DR severity per modified Davis staging; camera: NIDEK AFC-230.
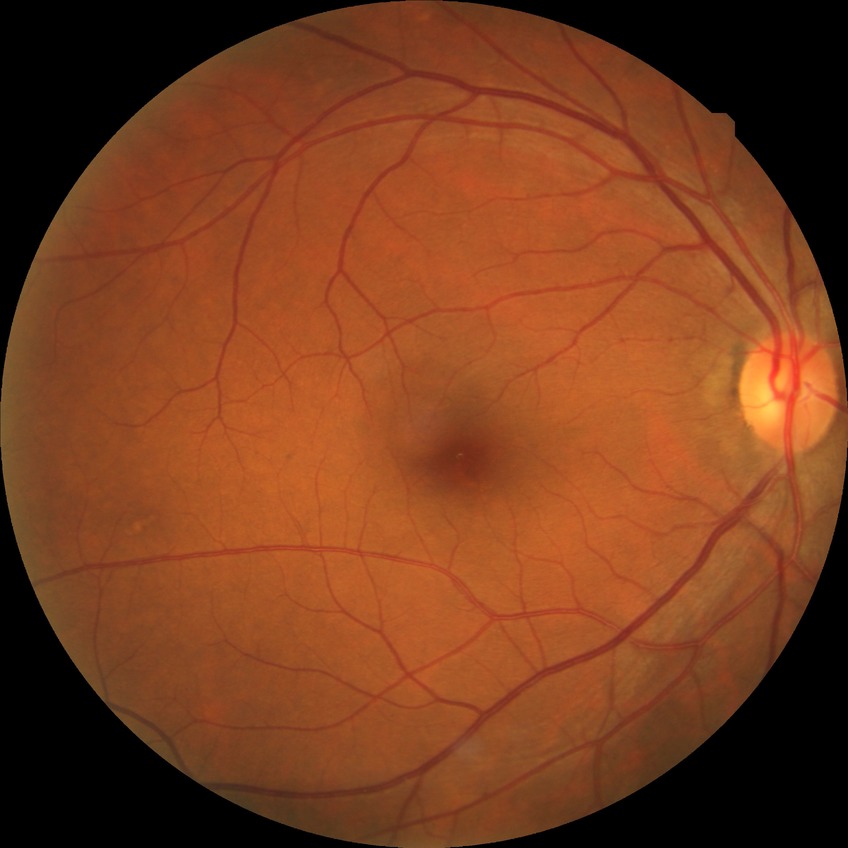 Diabetic retinopathy (DR) is NDR (no diabetic retinopathy).